Diabetic retinopathy graded by the modified Davis classification: 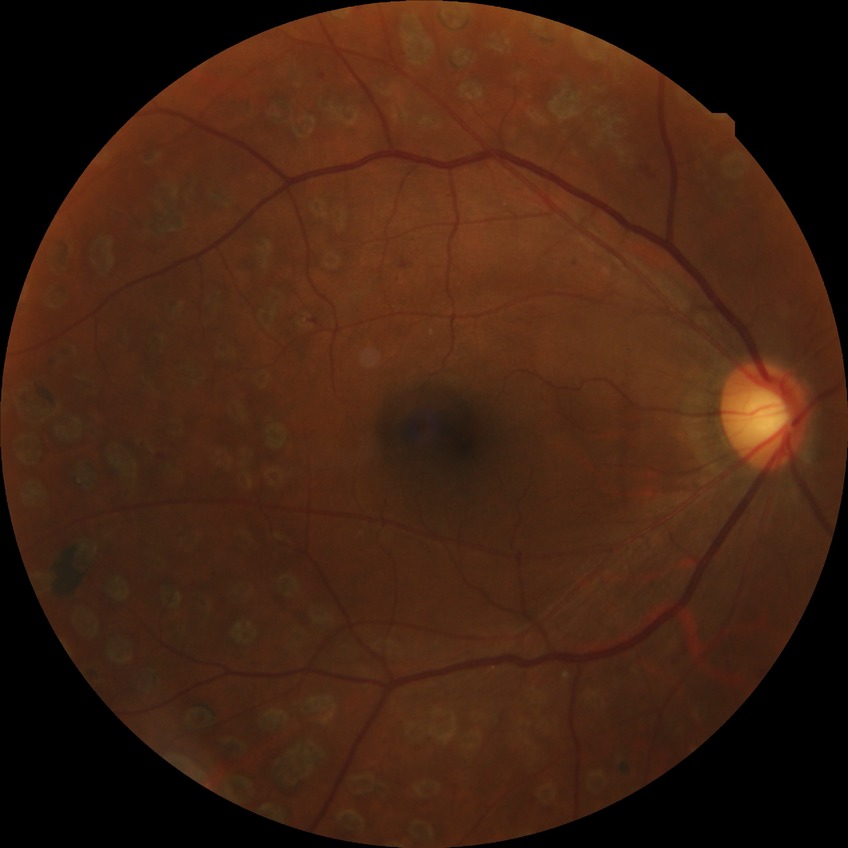 retinopathy grade: proliferative diabetic retinopathy.